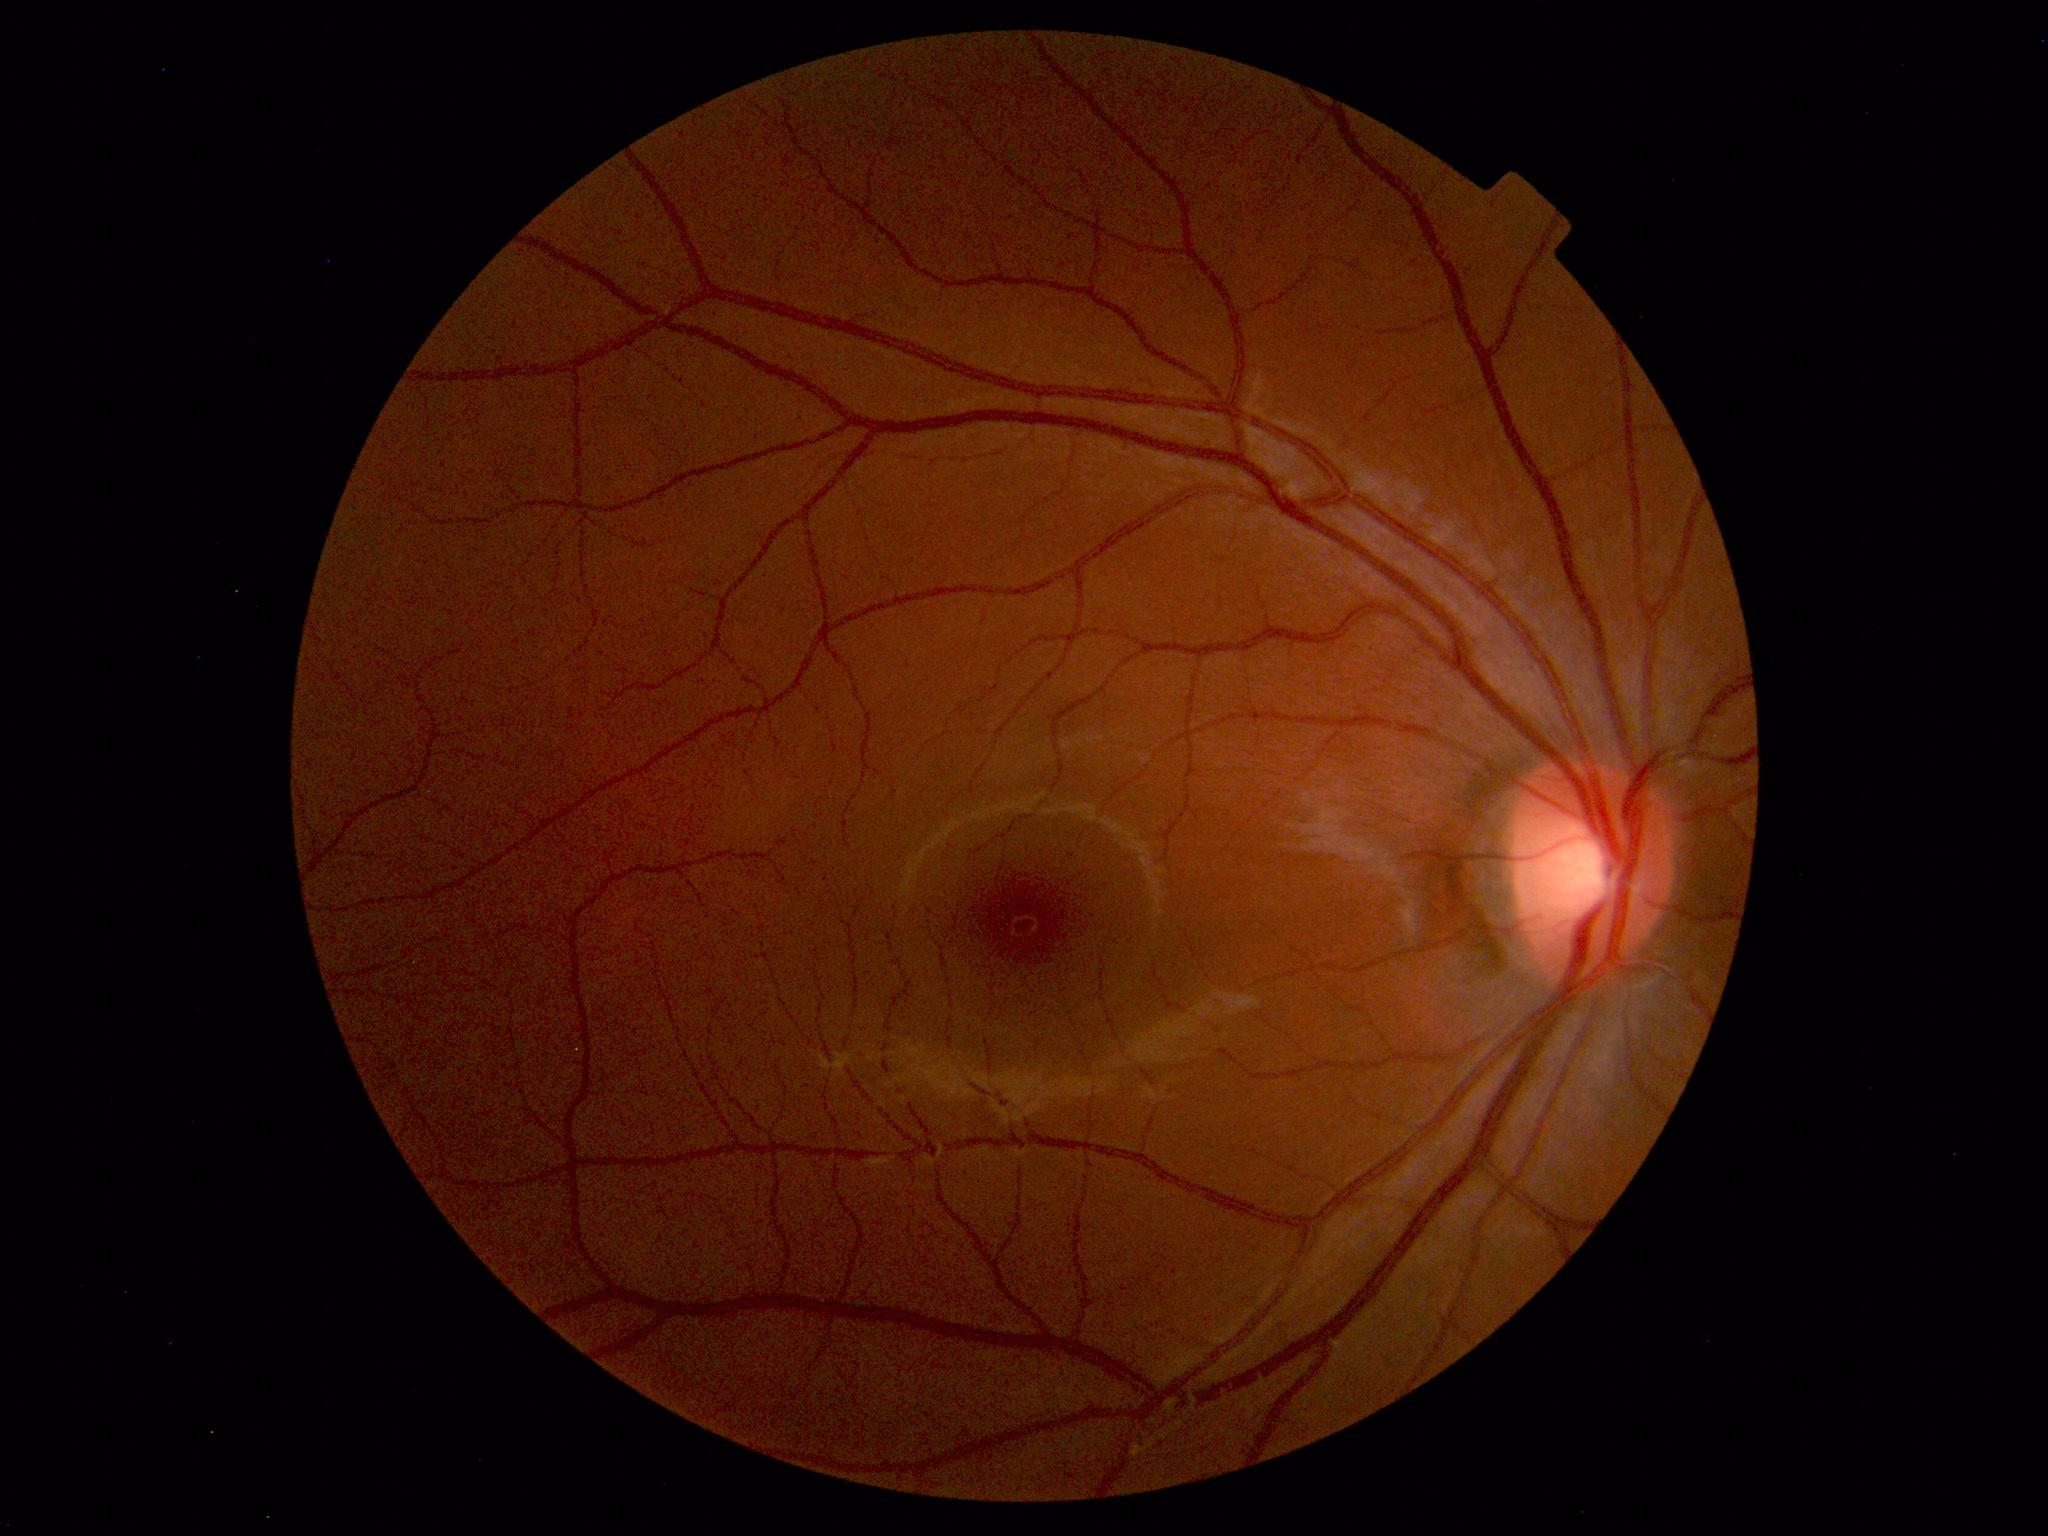

Within normal limits. No abnormalities identified.